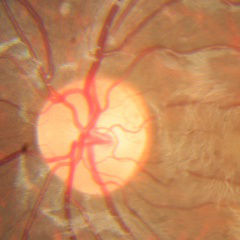
Q: What is the glaucoma diagnosis?
A: No glaucoma.